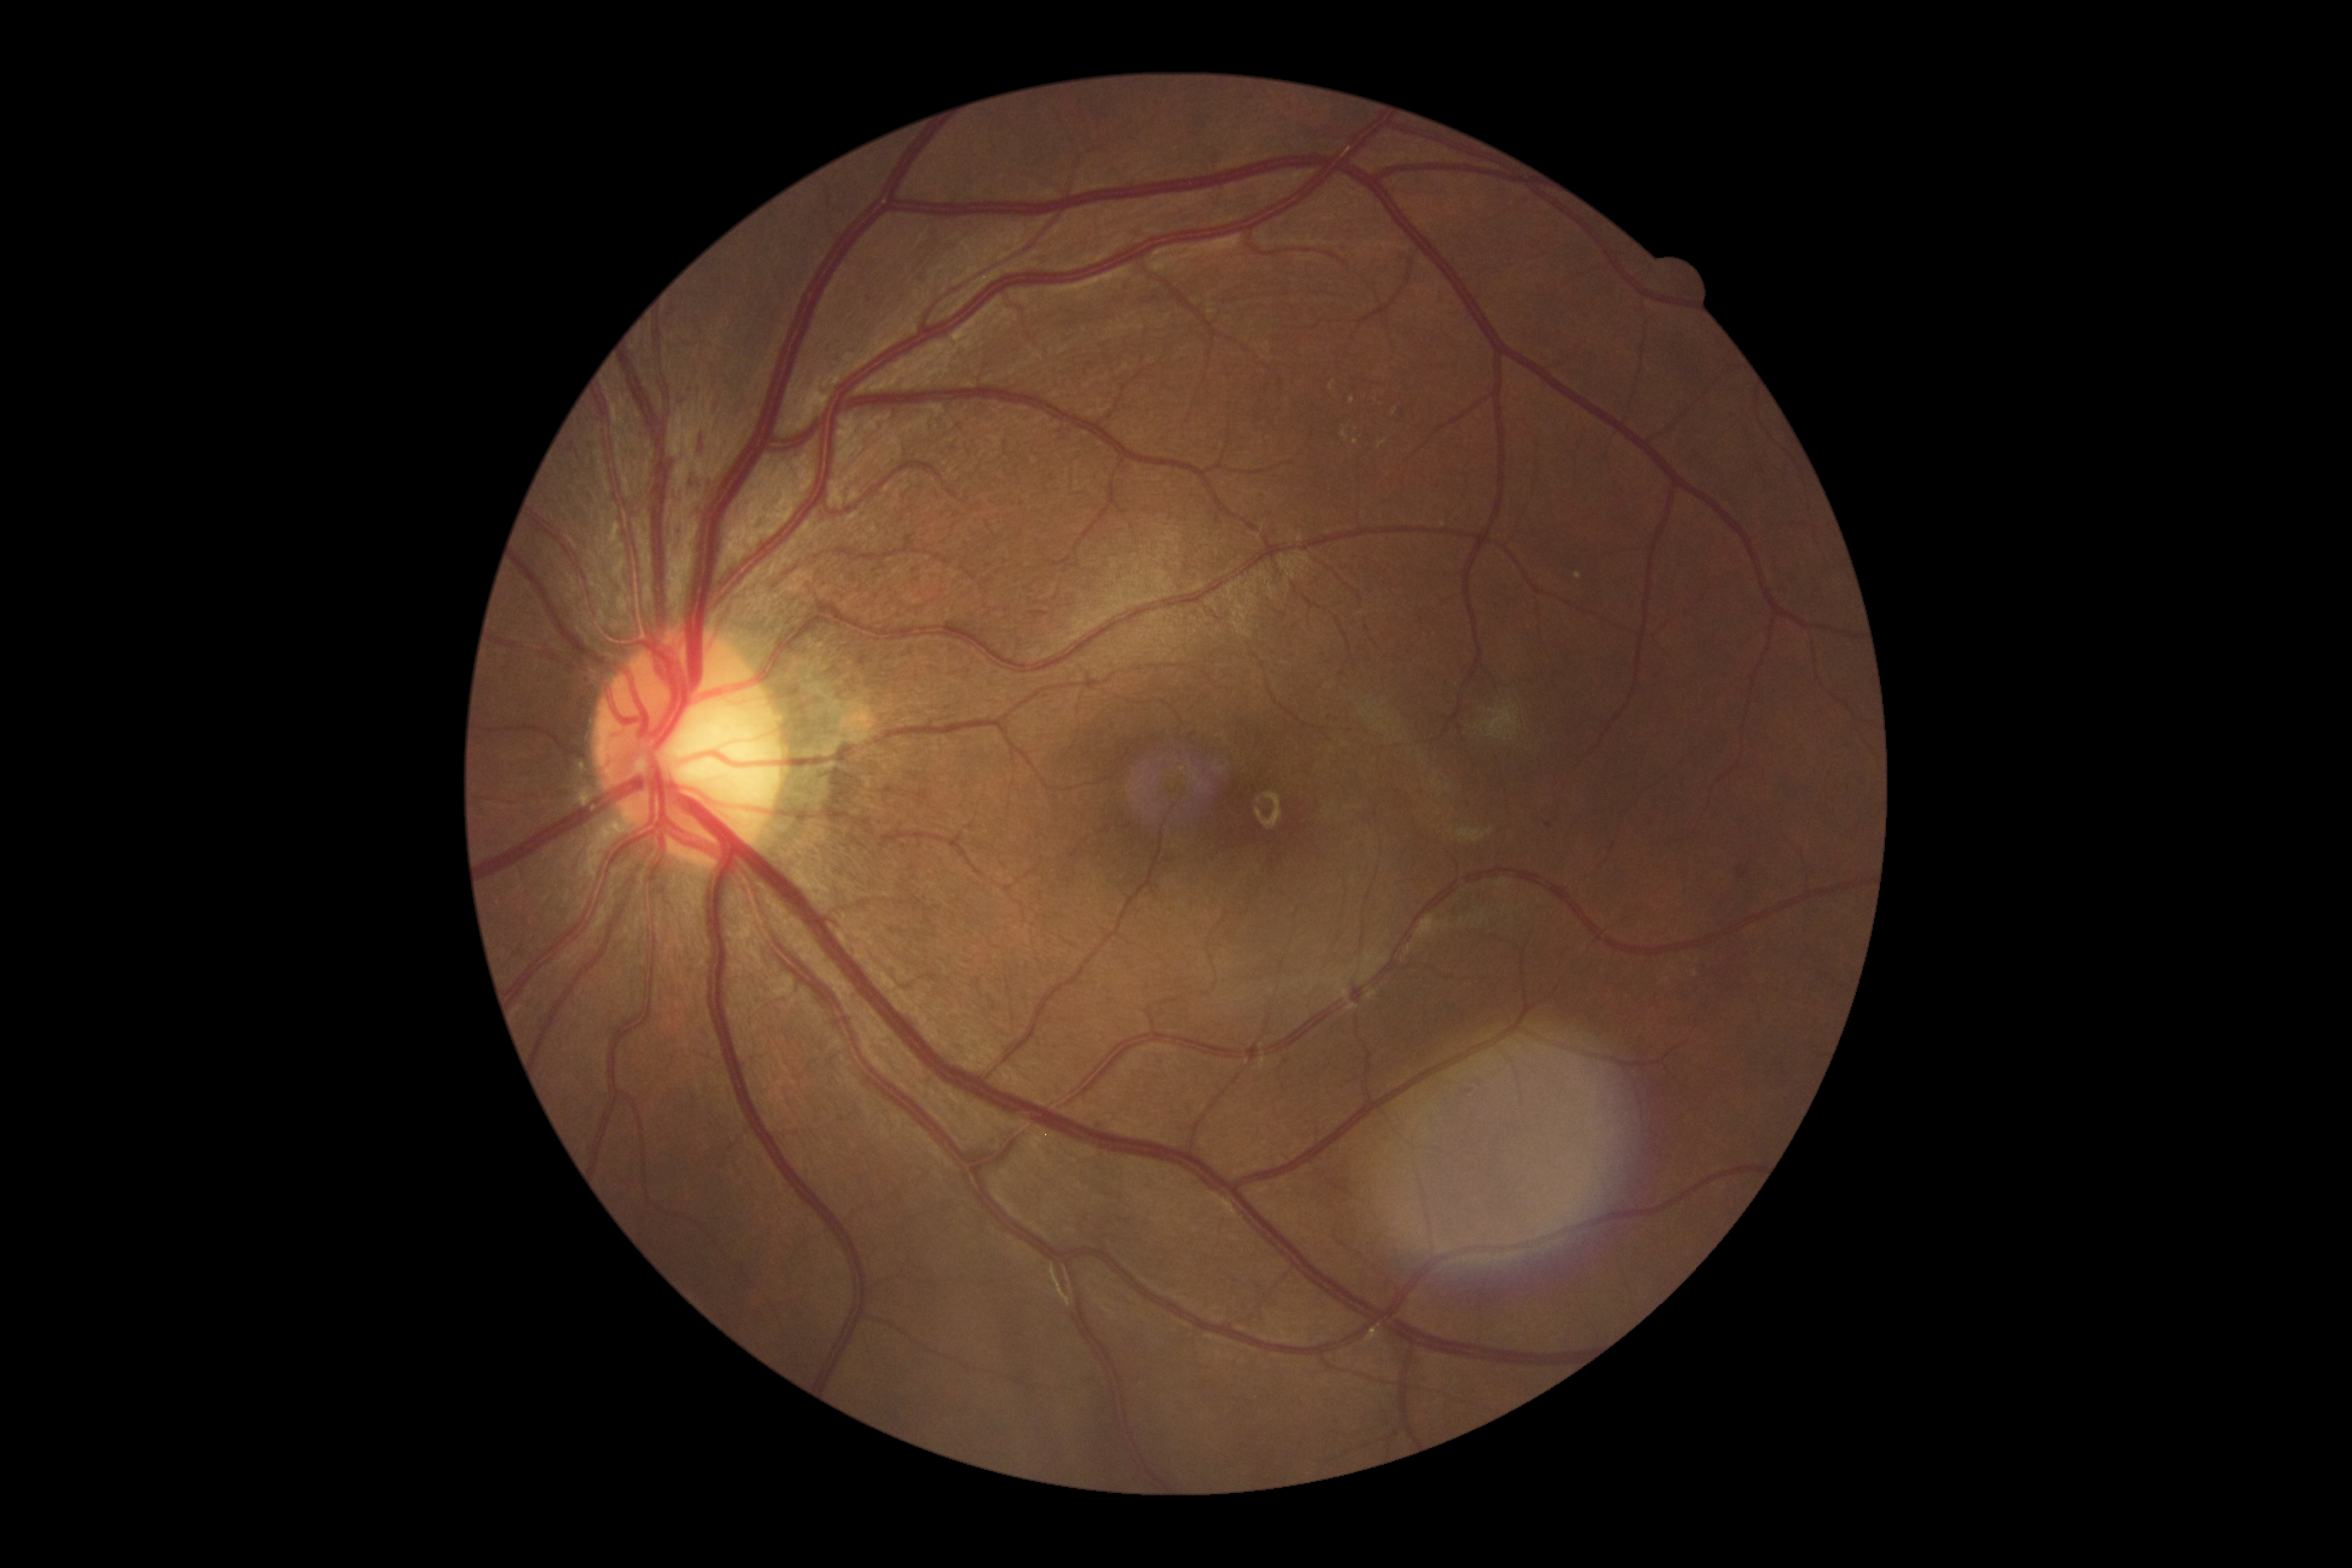 DR severity is grade 2 (moderate NPDR) — more than just microaneurysms but less than severe NPDR.